Pediatric retinal photograph (wide-field); 640 by 480 pixels — 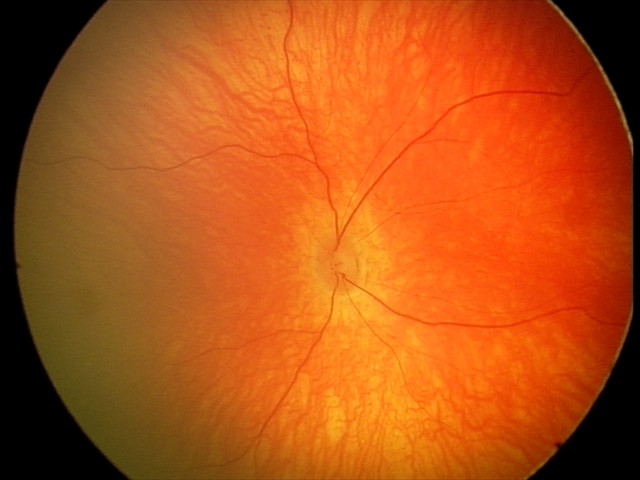

Screening examination with no abnormal retinal findings.